Image size 2352x1568. CFP:
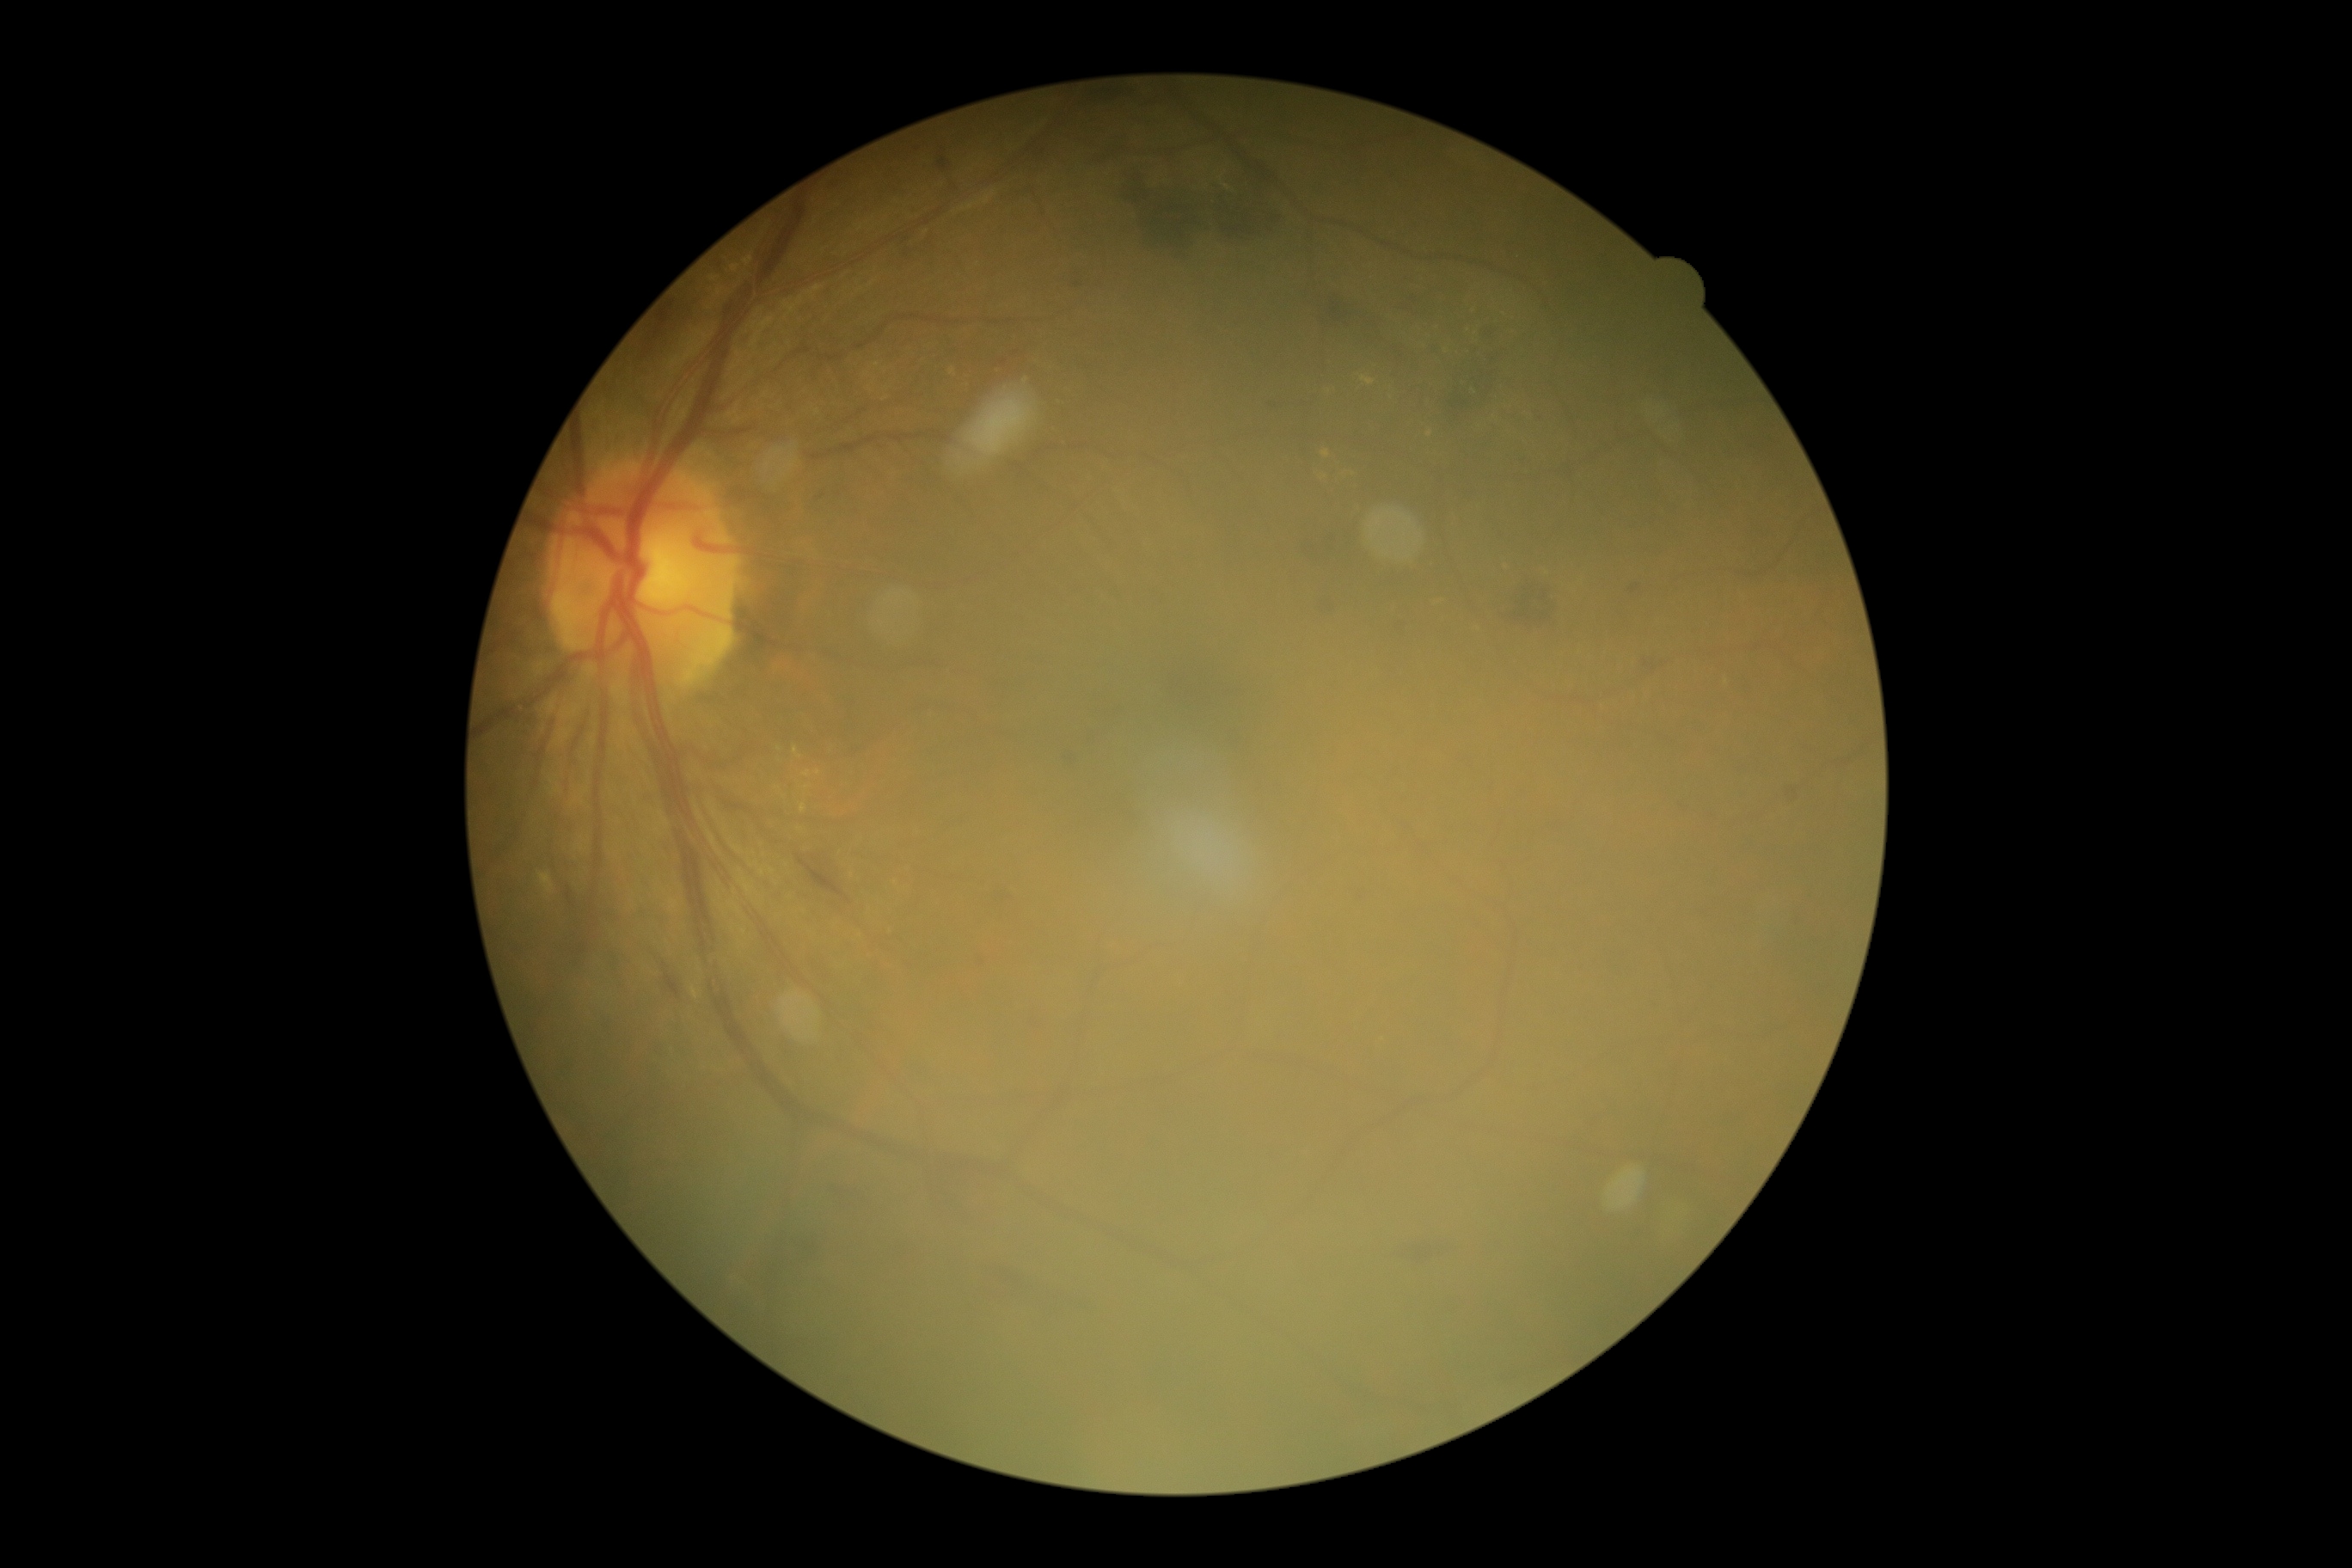
Diabetic retinopathy severity: moderate NPDR (grade 2).